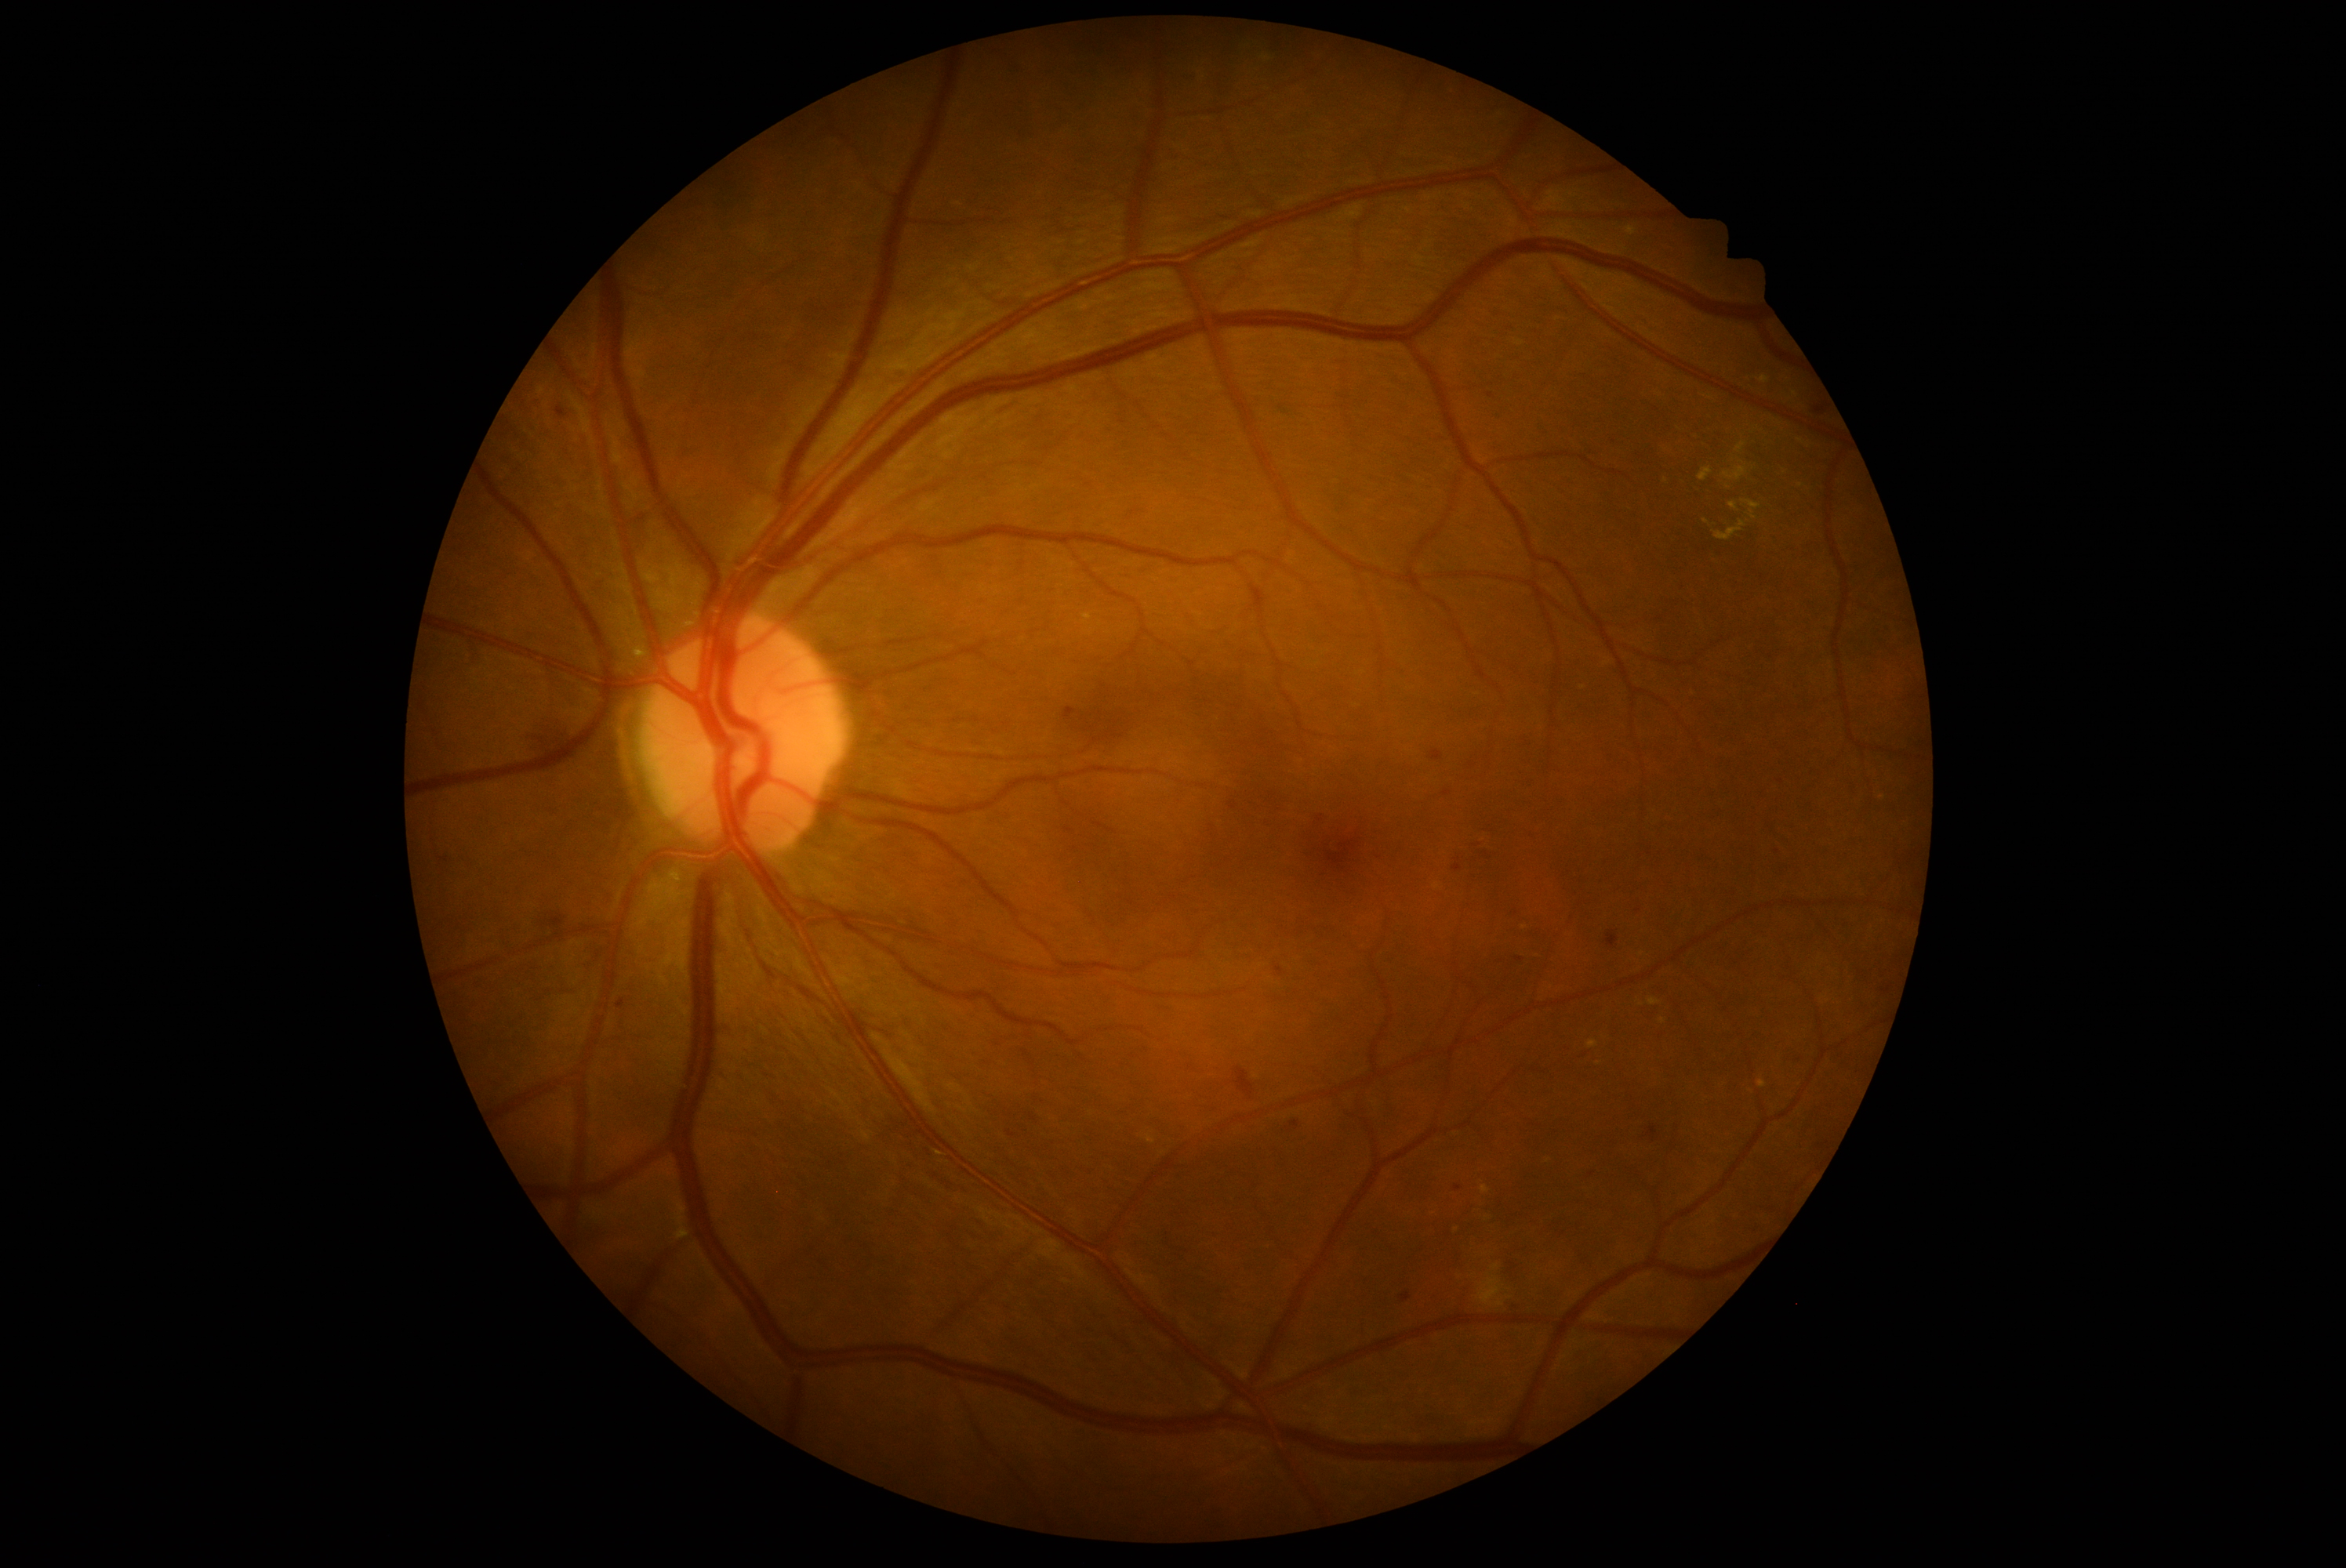

DR: grade 2 (moderate NPDR) — more than just microaneurysms but less than severe NPDR.